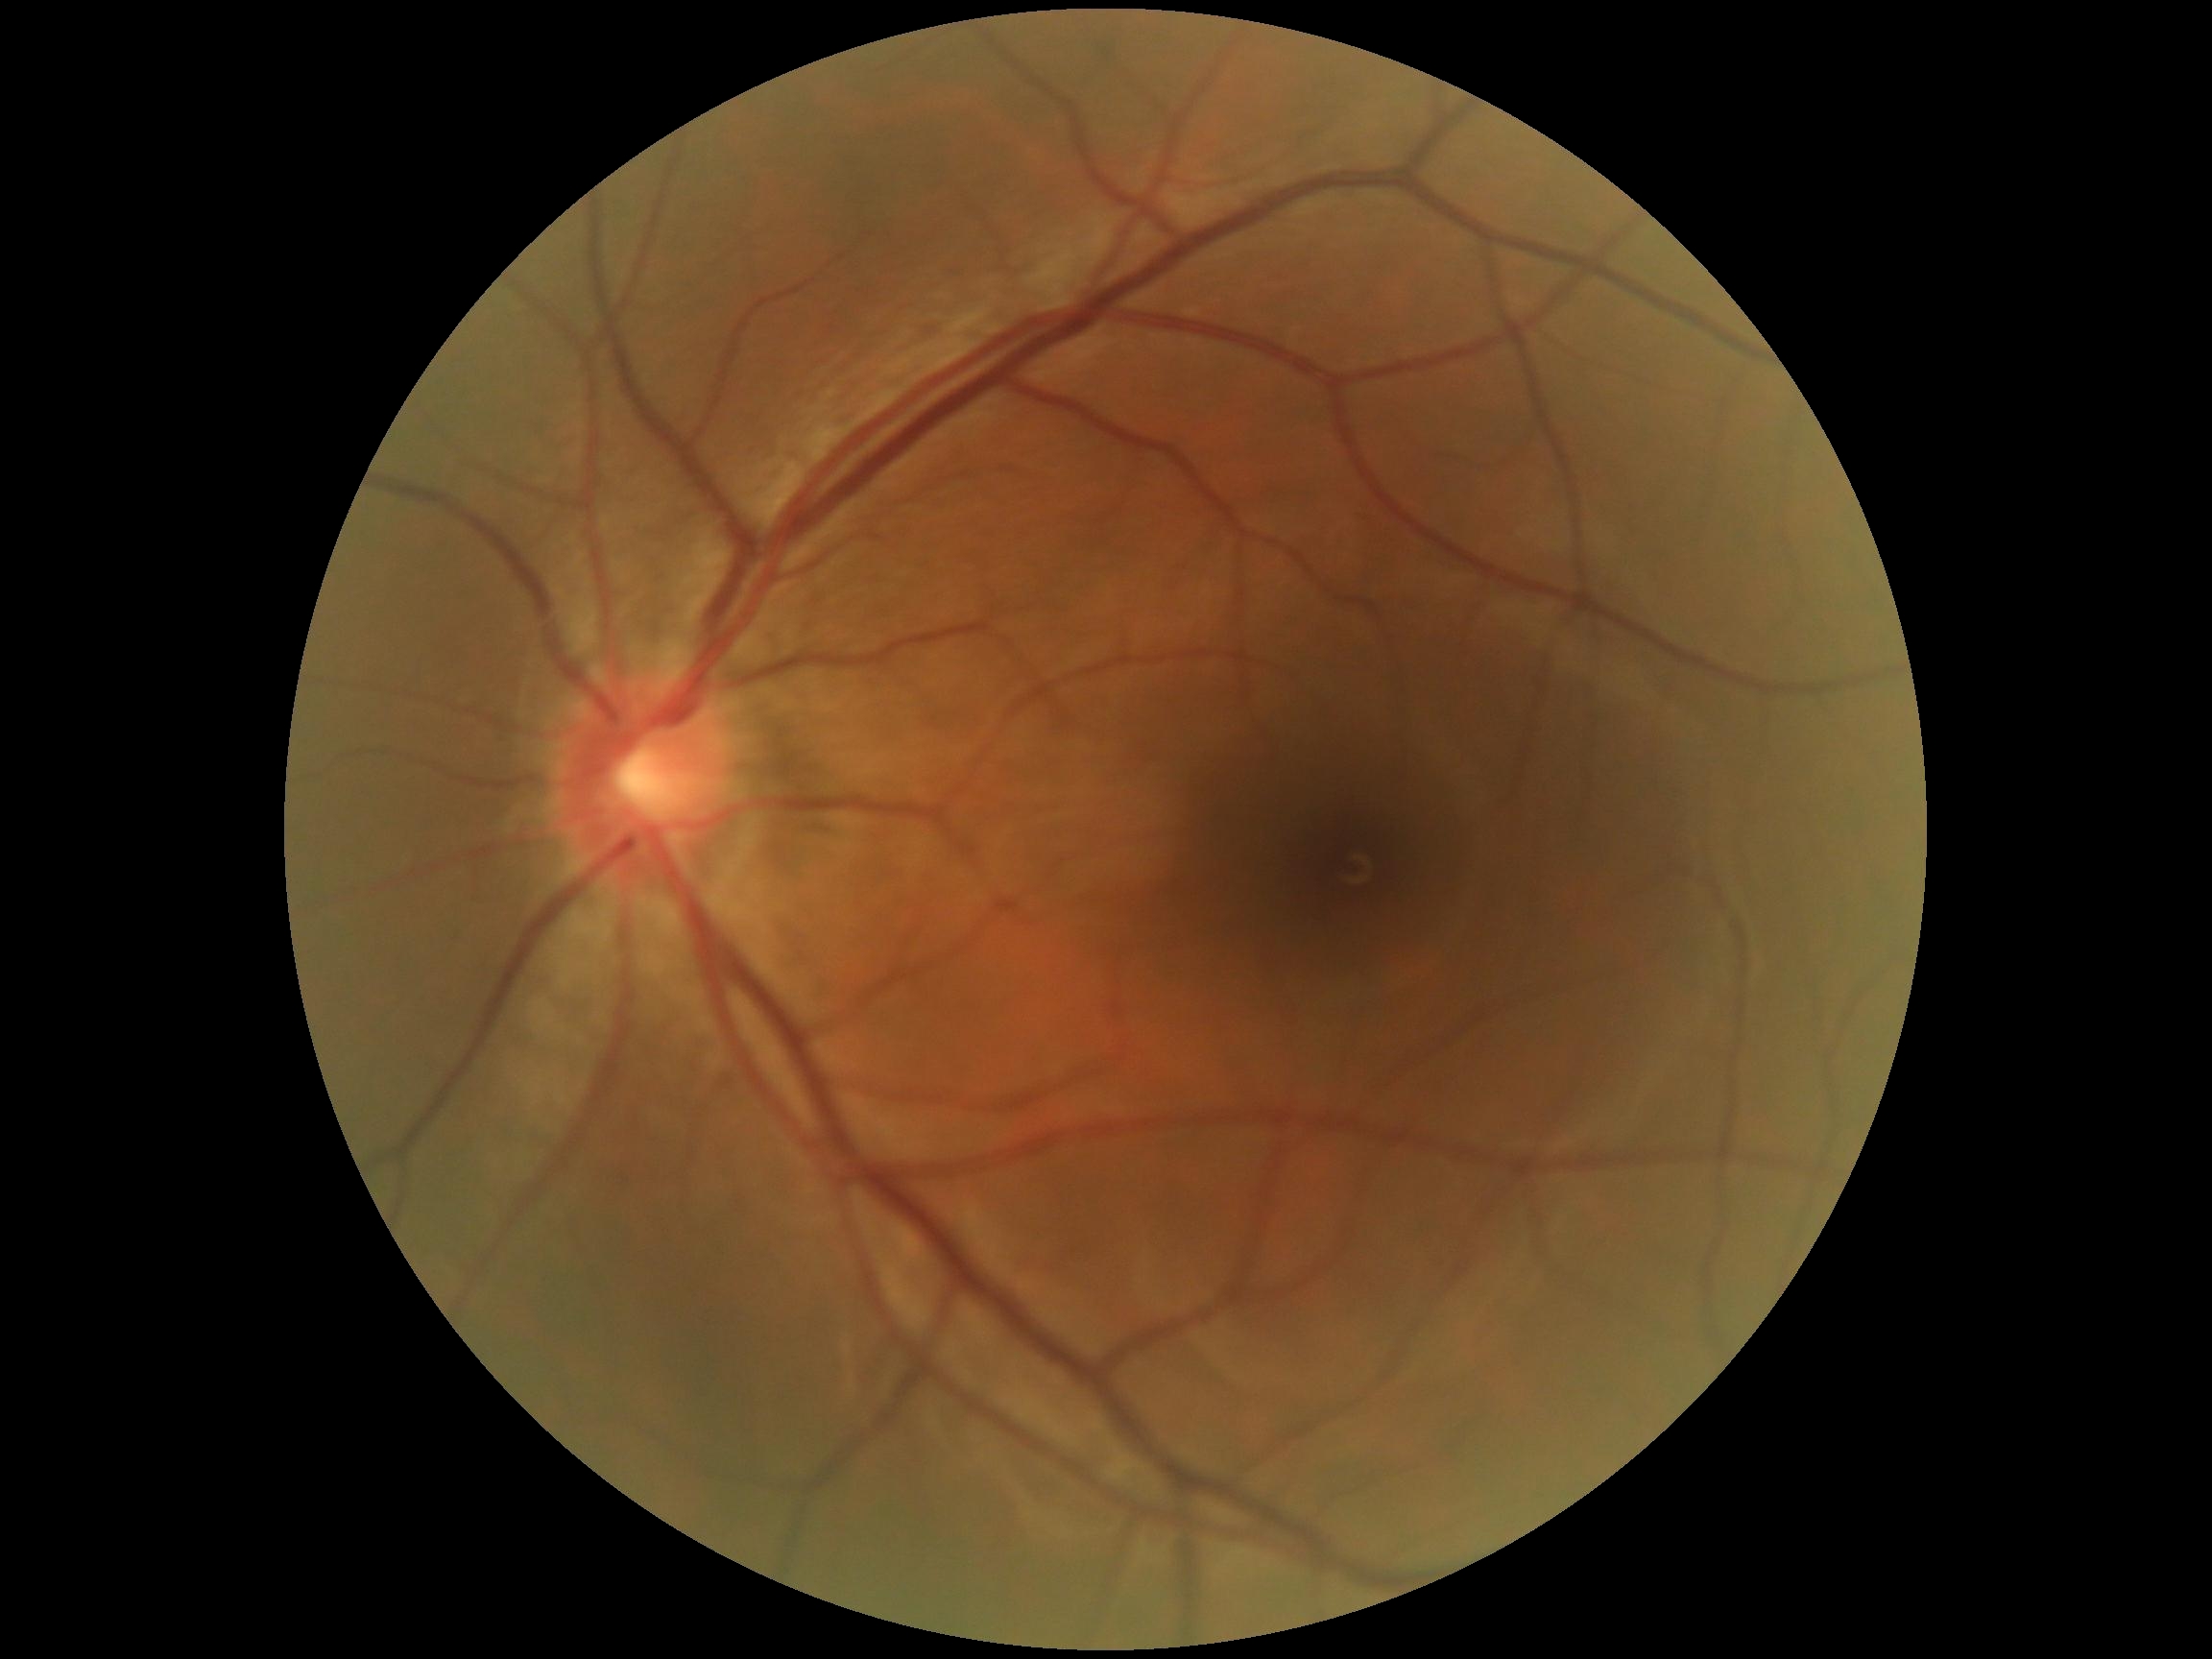
{"dr_impression": "no DR findings", "dr_grade": "grade 0 (no apparent retinopathy)"}